Without pupil dilation. NIDEK AFC-230. Posterior pole color fundus photograph. 848 x 848 pixels
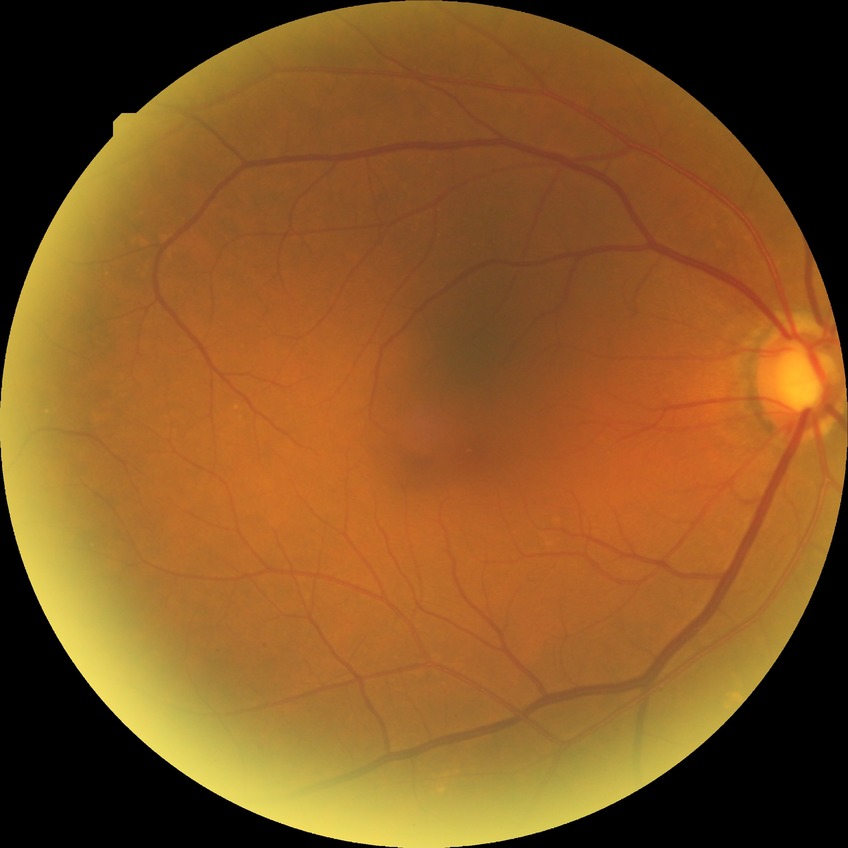
diabetic retinopathy (DR): simple diabetic retinopathy (SDR).